Acquired with a Nidek AFC-330, color fundus photograph, non-mydriatic fundus camera:
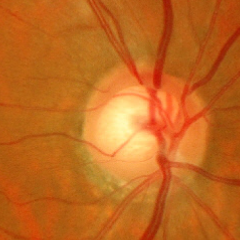
Q: Does this eye have glaucoma?
A: Yes — early glaucoma.